Remidio Fundus on Phone (FOP) camera, 1659 by 2212 pixels.
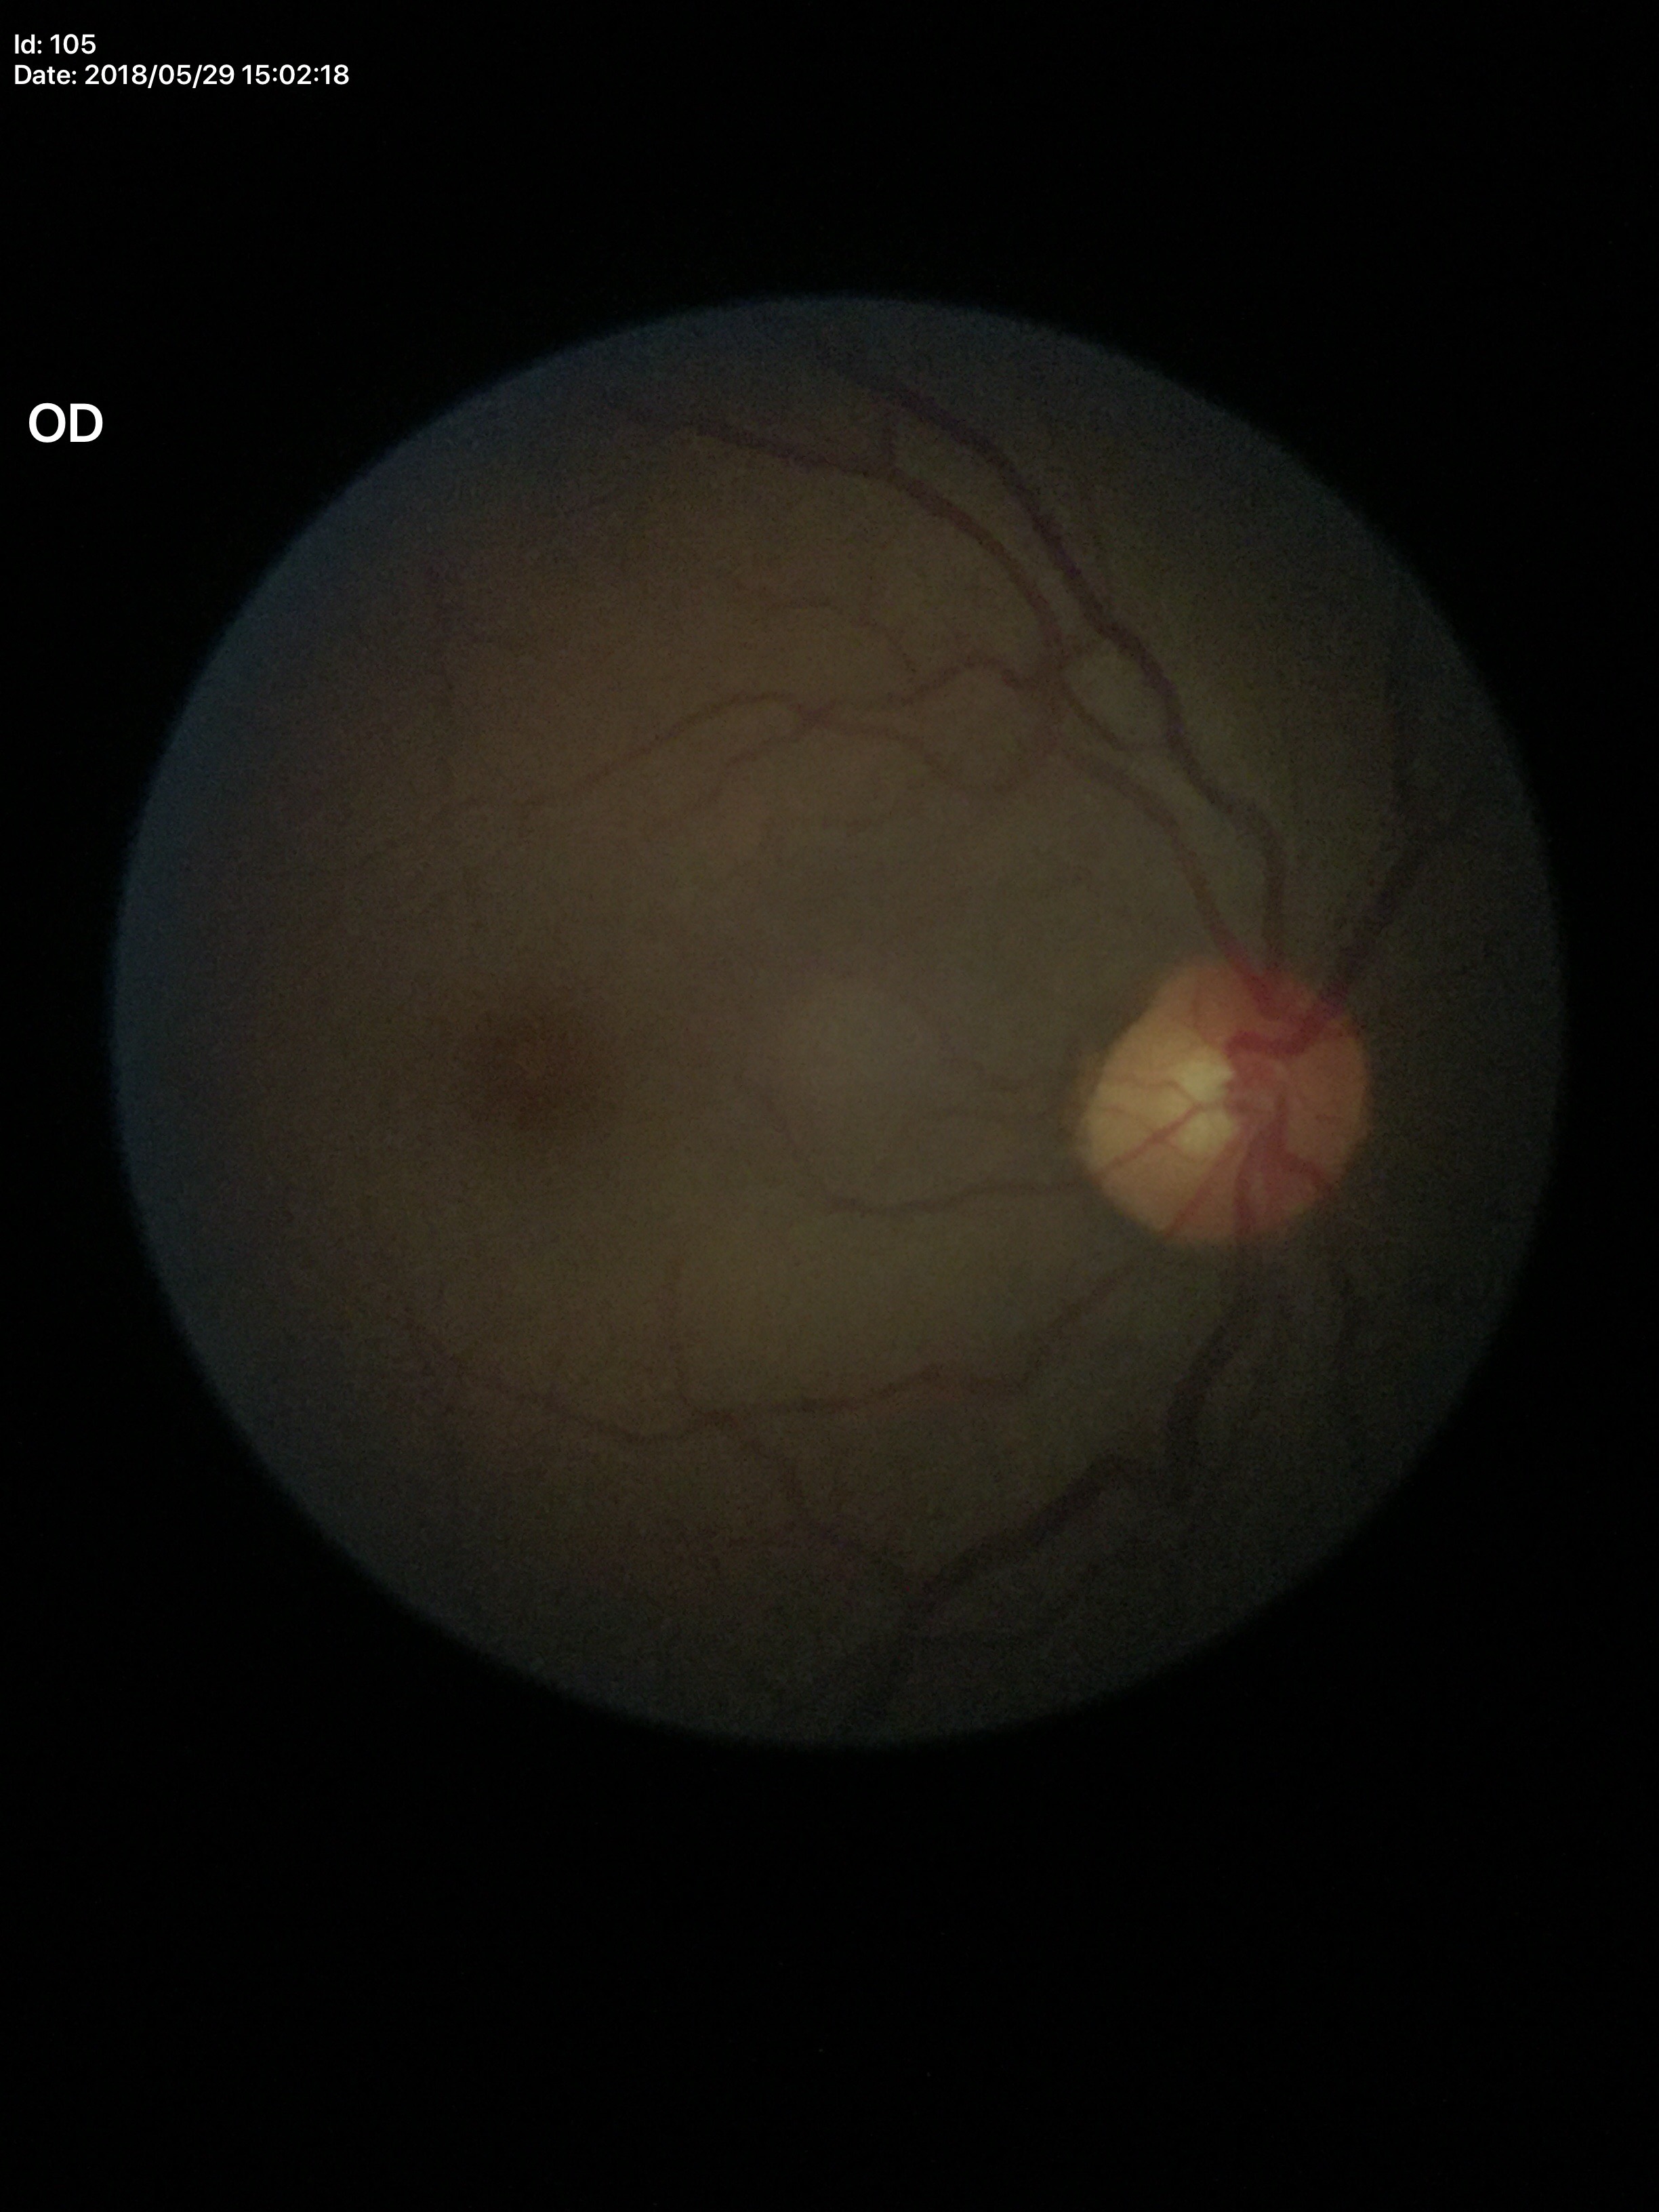 Glaucoma decision: negative. Vertical C/D ratio of 0.49.